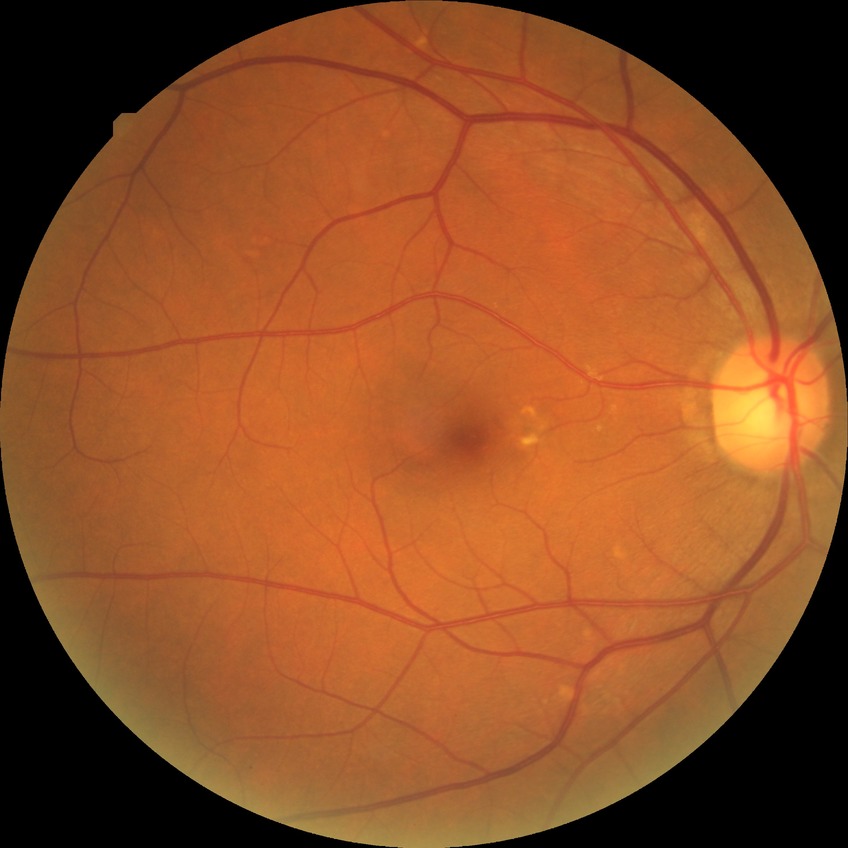
Diabetic retinopathy (DR) is no diabetic retinopathy (NDR).